Fundus photo. 2212x1659px. 45° field of view:
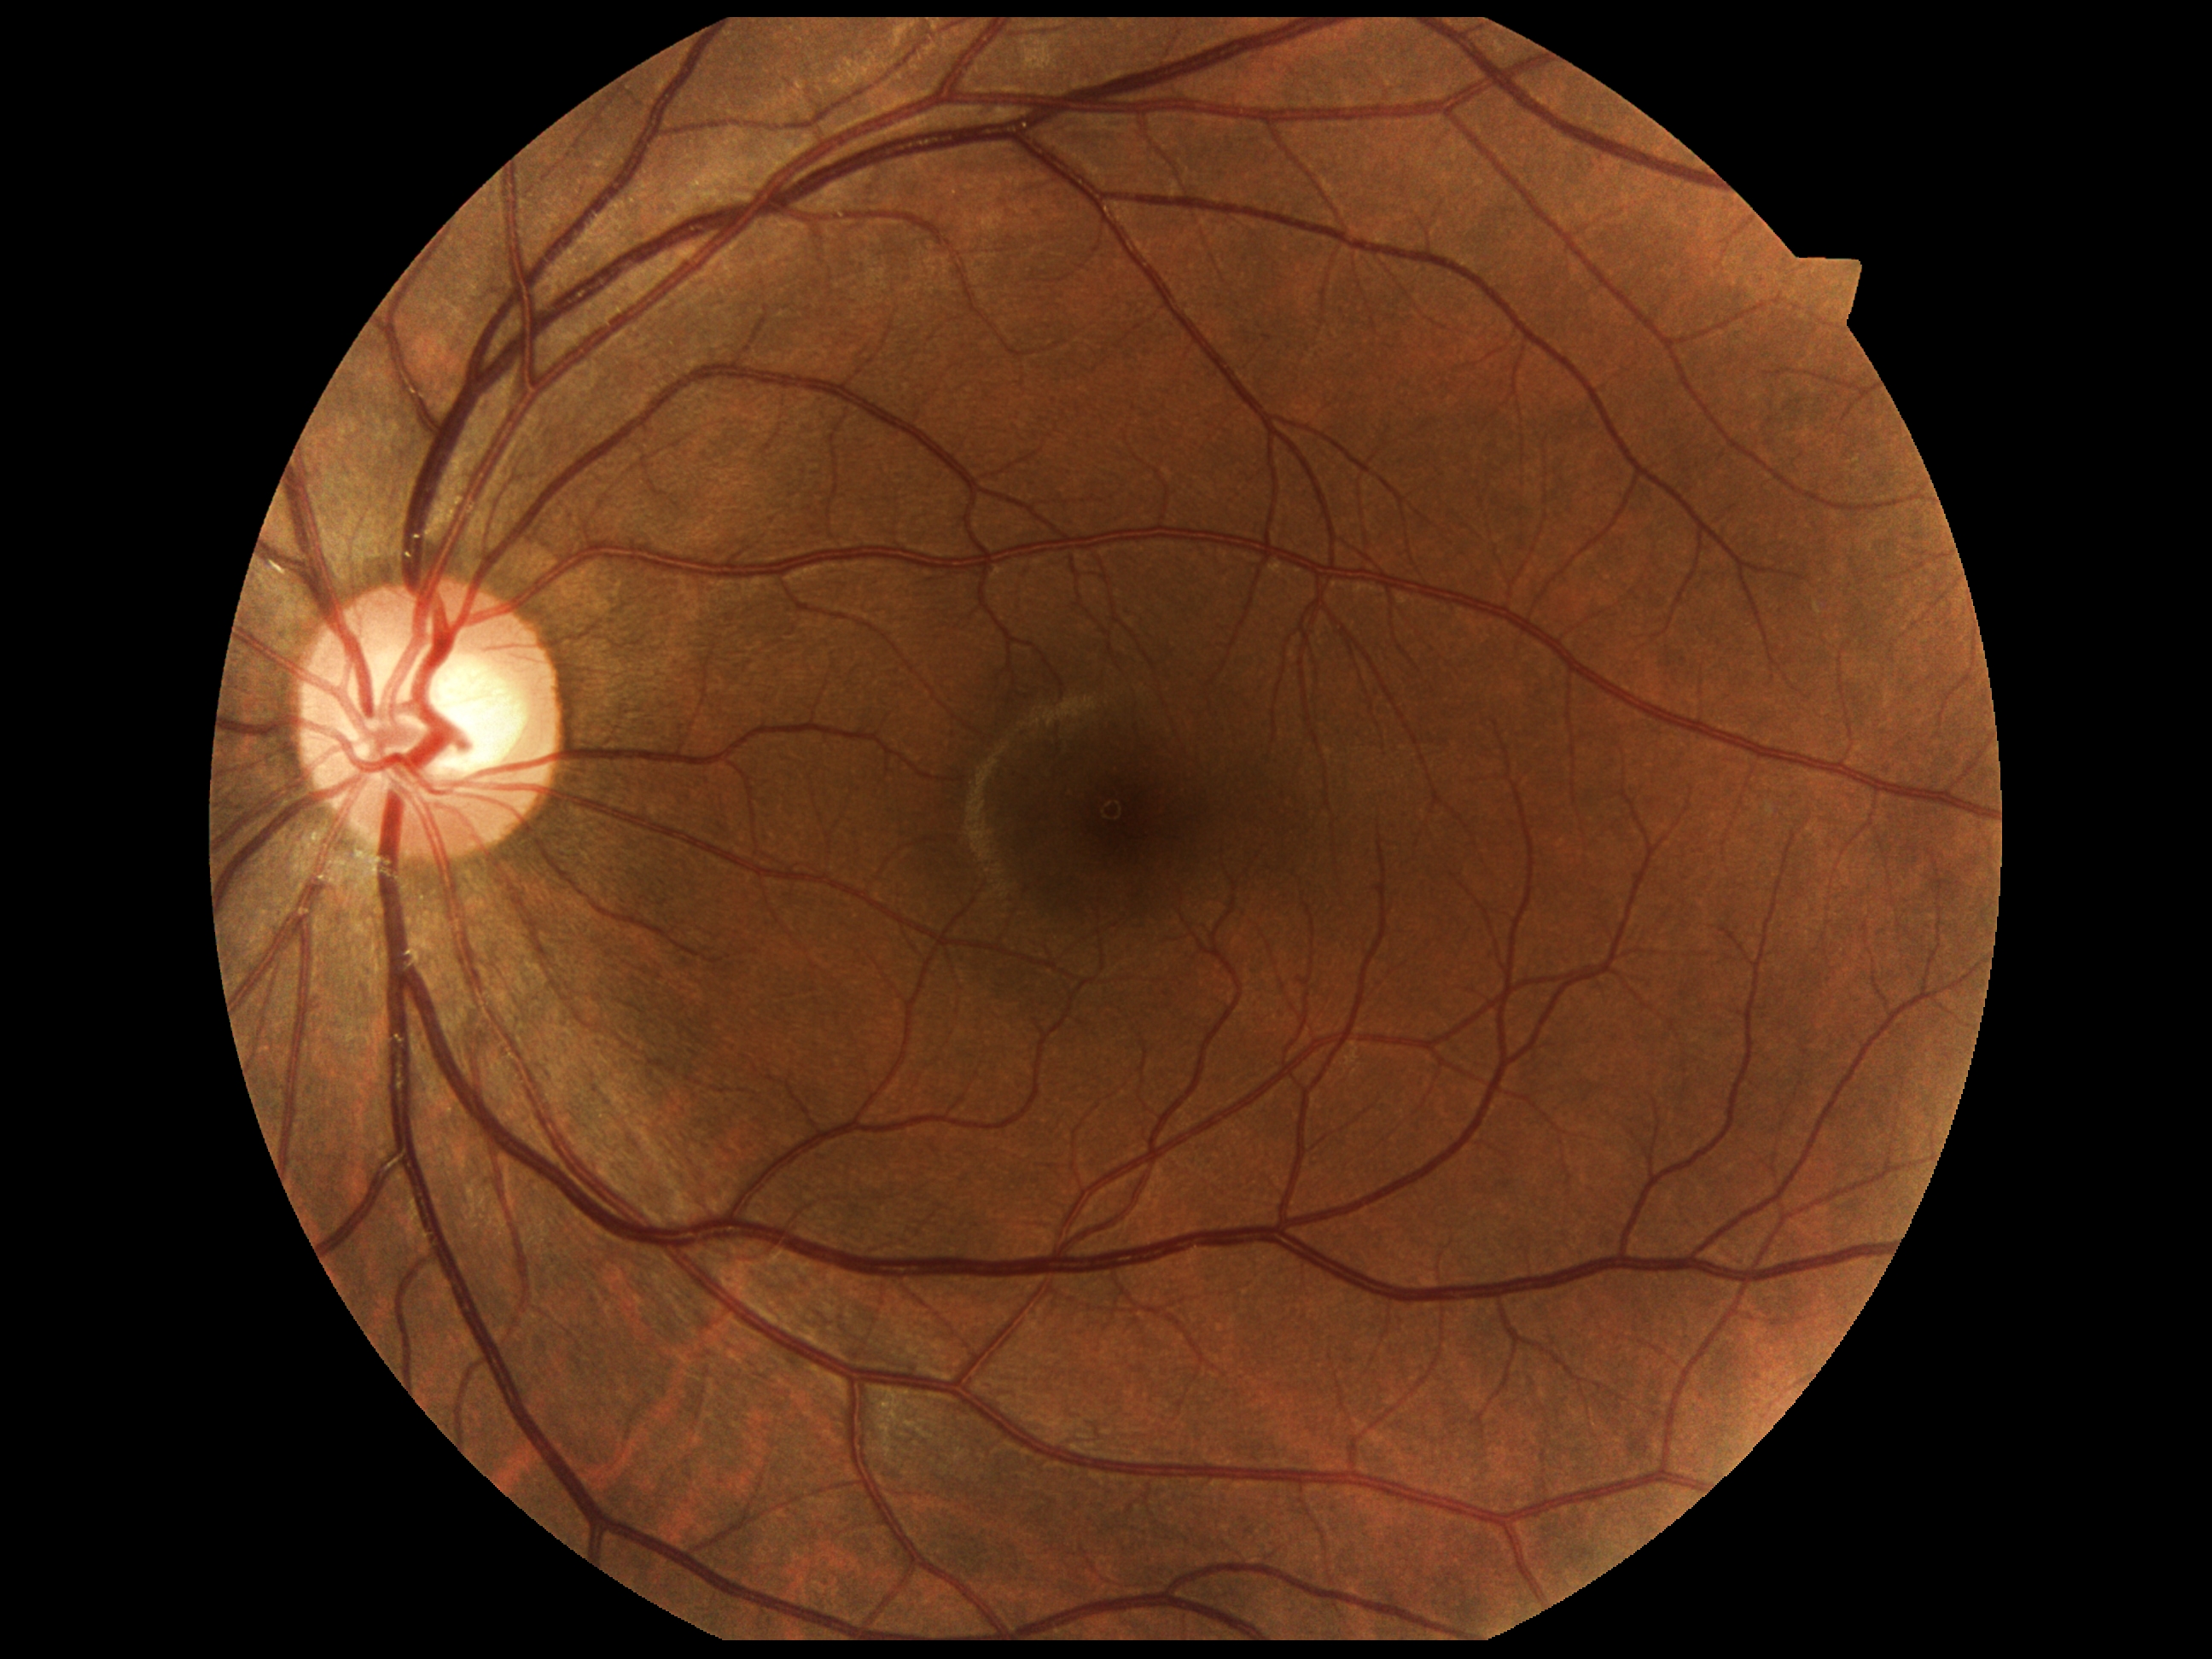

Findings:
– DR impression — no DR findings
– DR grade — 0 (no apparent retinopathy)